Color fundus photograph, image size 1960x1897: 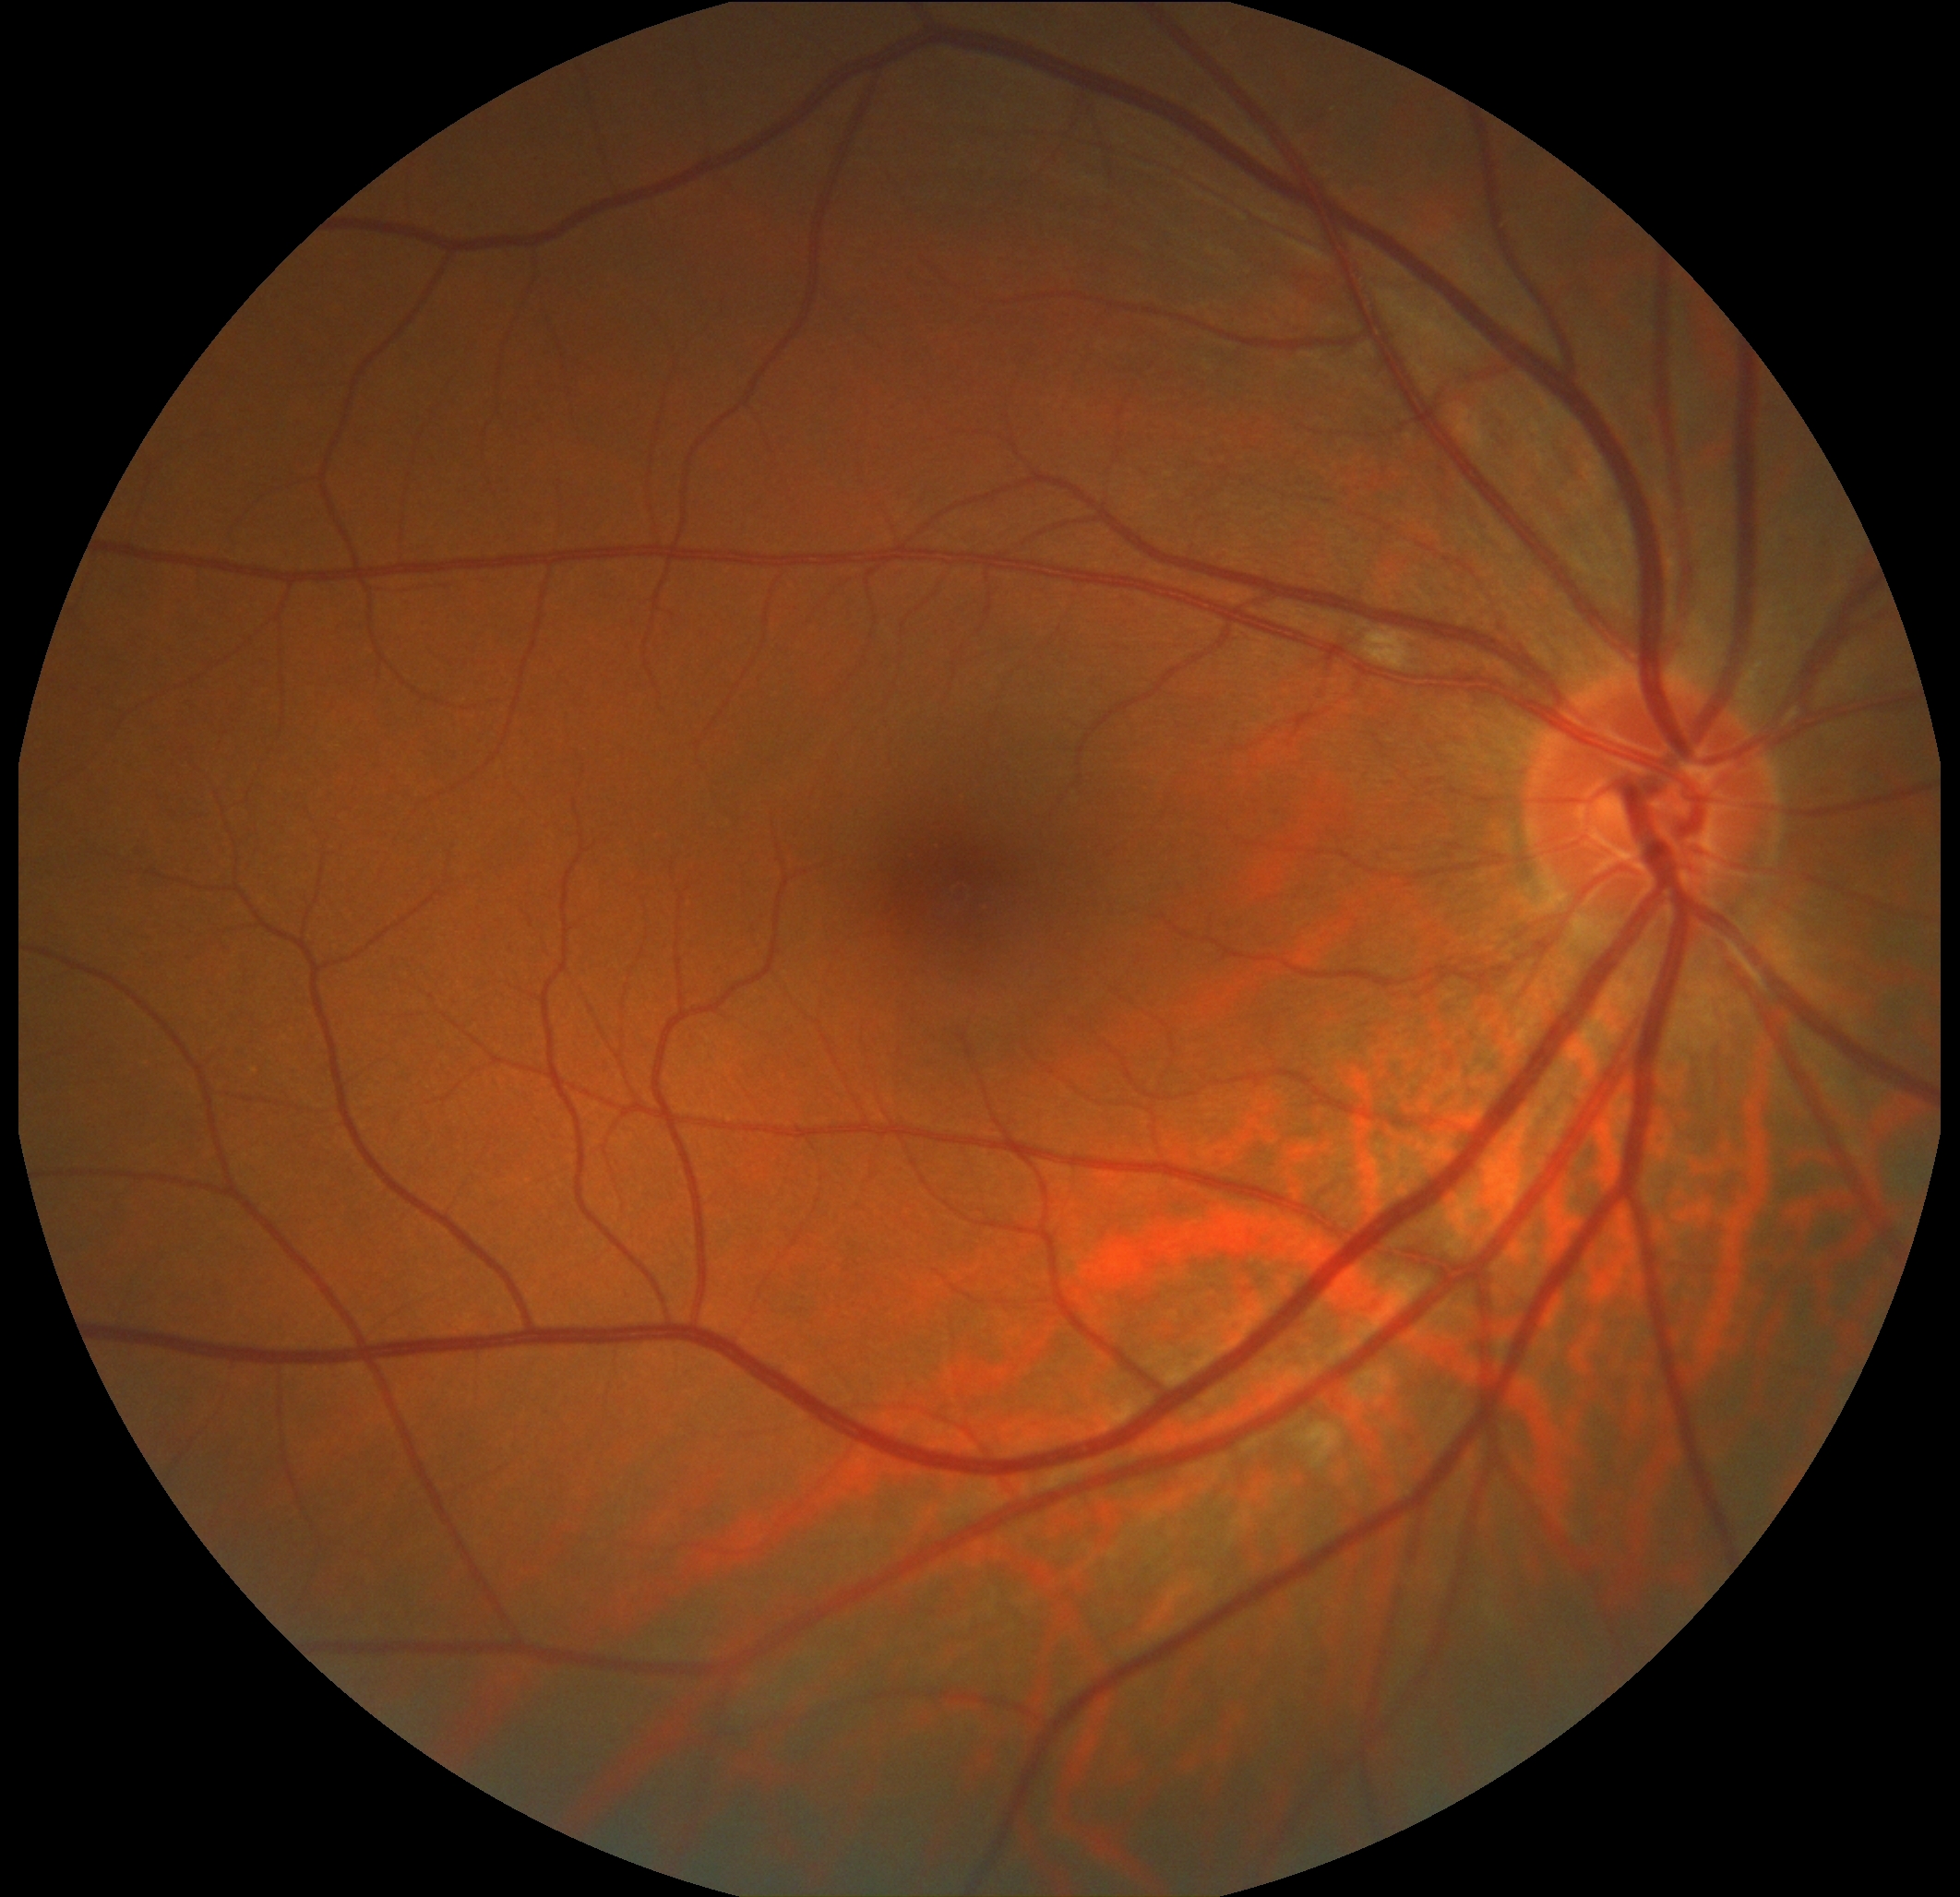

retinopathy grade = 2 (moderate NPDR) — more than just microaneurysms but less than severe NPDR.